Posterior pole color fundus photograph; 848x848; NIDEK AFC-230 fundus camera
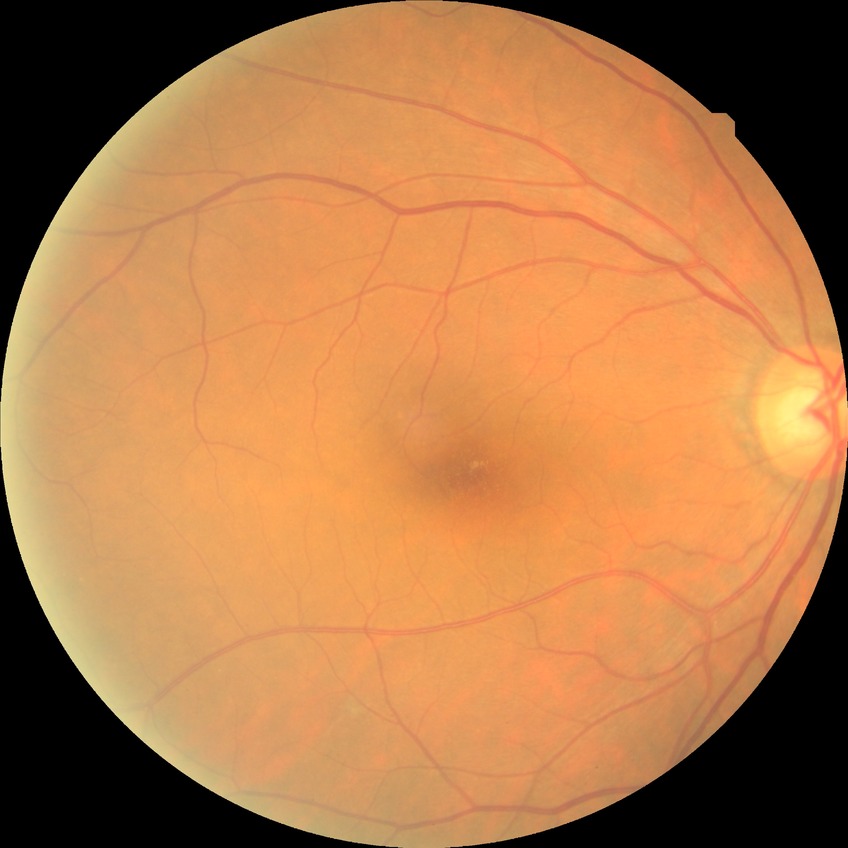 Modified Davis classification: no diabetic retinopathy.